Wide-field fundus photograph from neonatal ROP screening · 640 by 480 pixels: 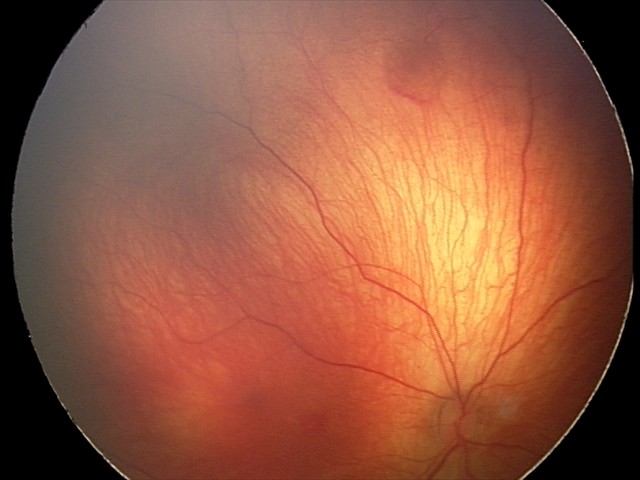

Series diagnosed as retinal hemorrhages.